Color fundus photograph: 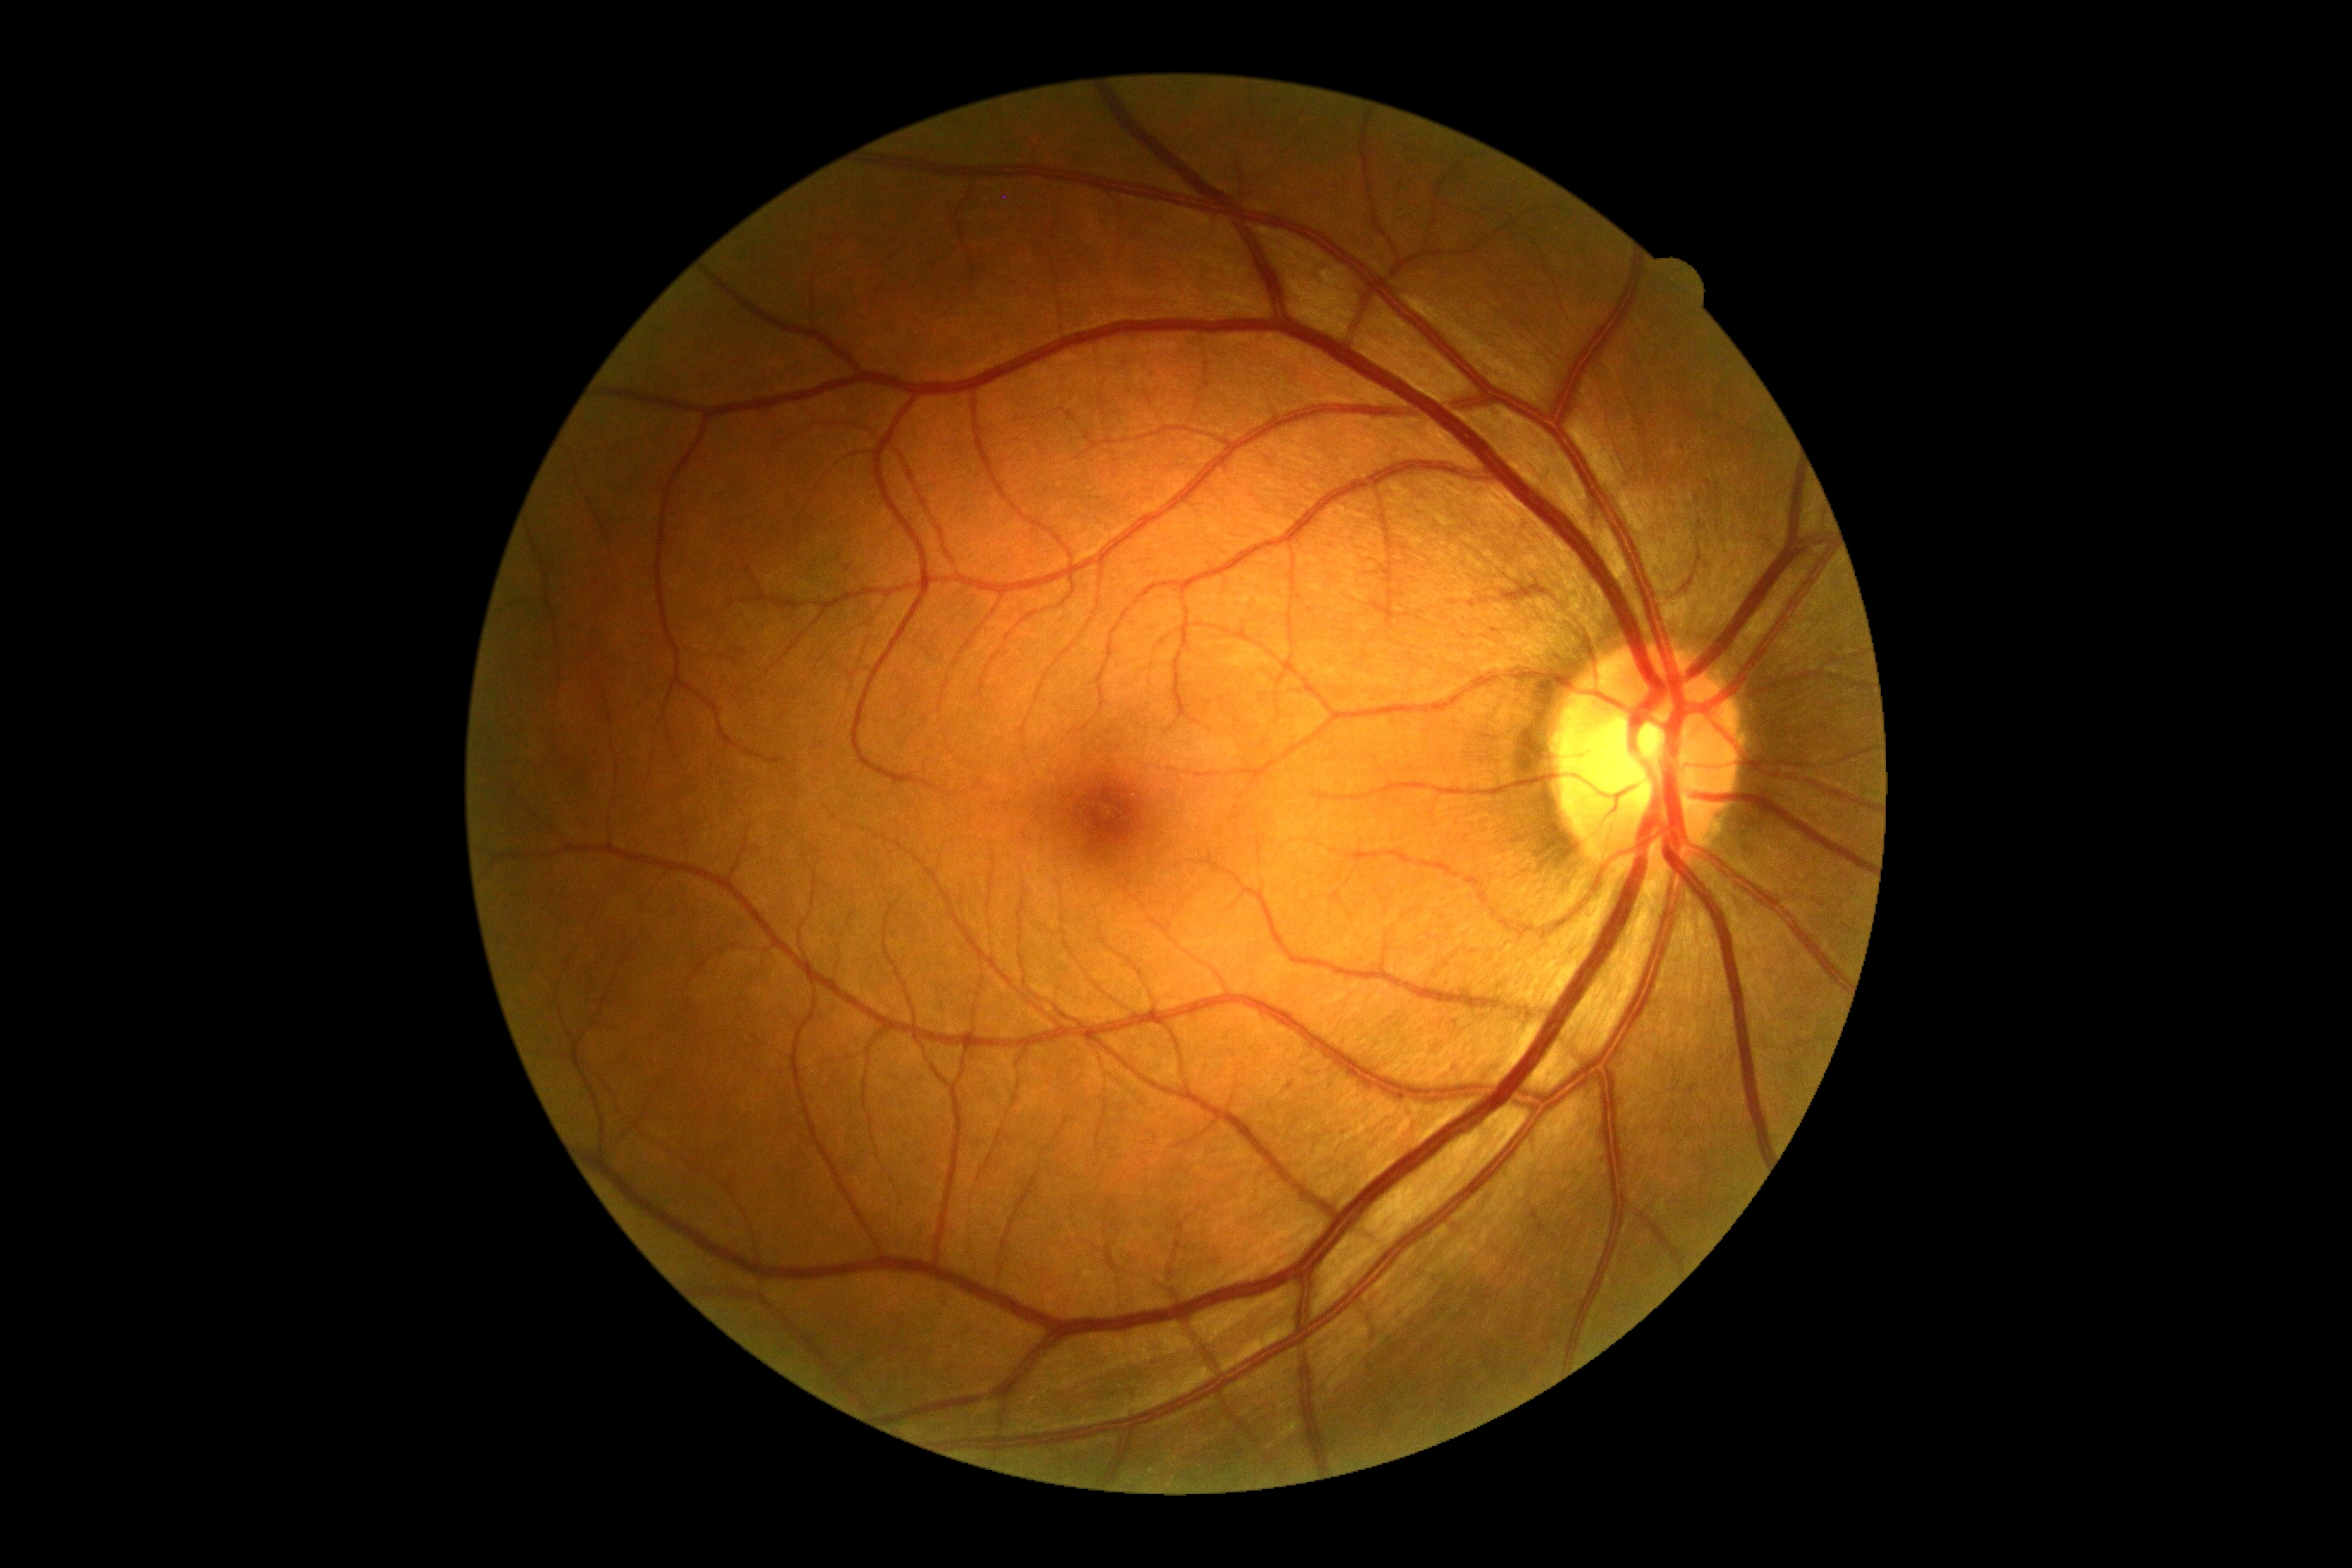
DR grade is 0/4.